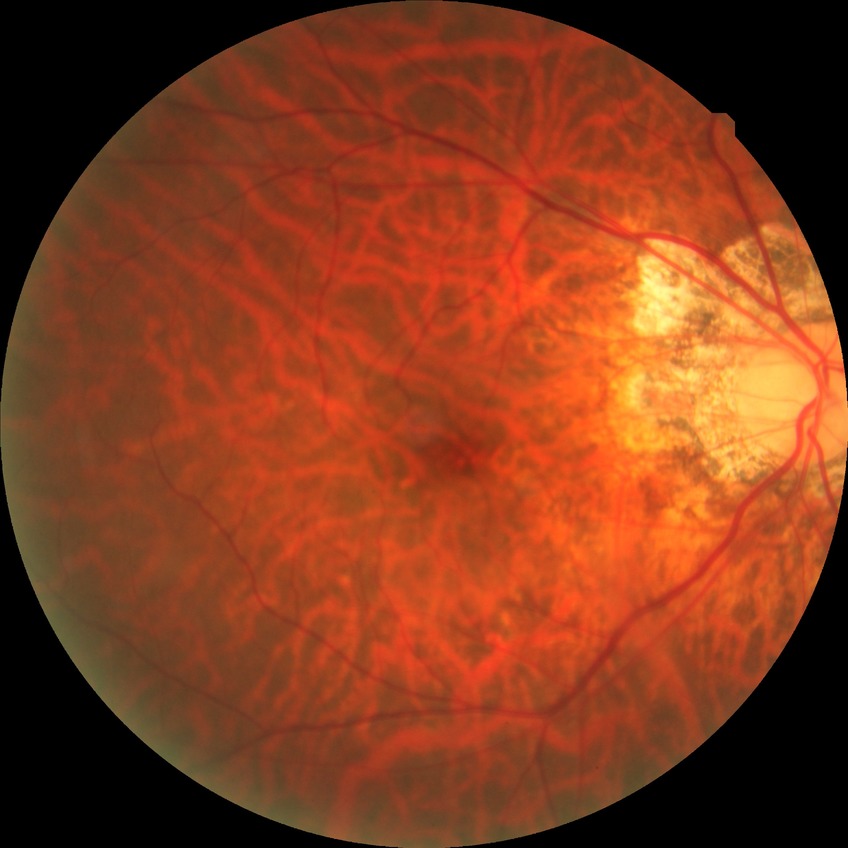

Diabetic retinopathy (DR): no diabetic retinopathy (NDR).